Image size 2048x1536 — 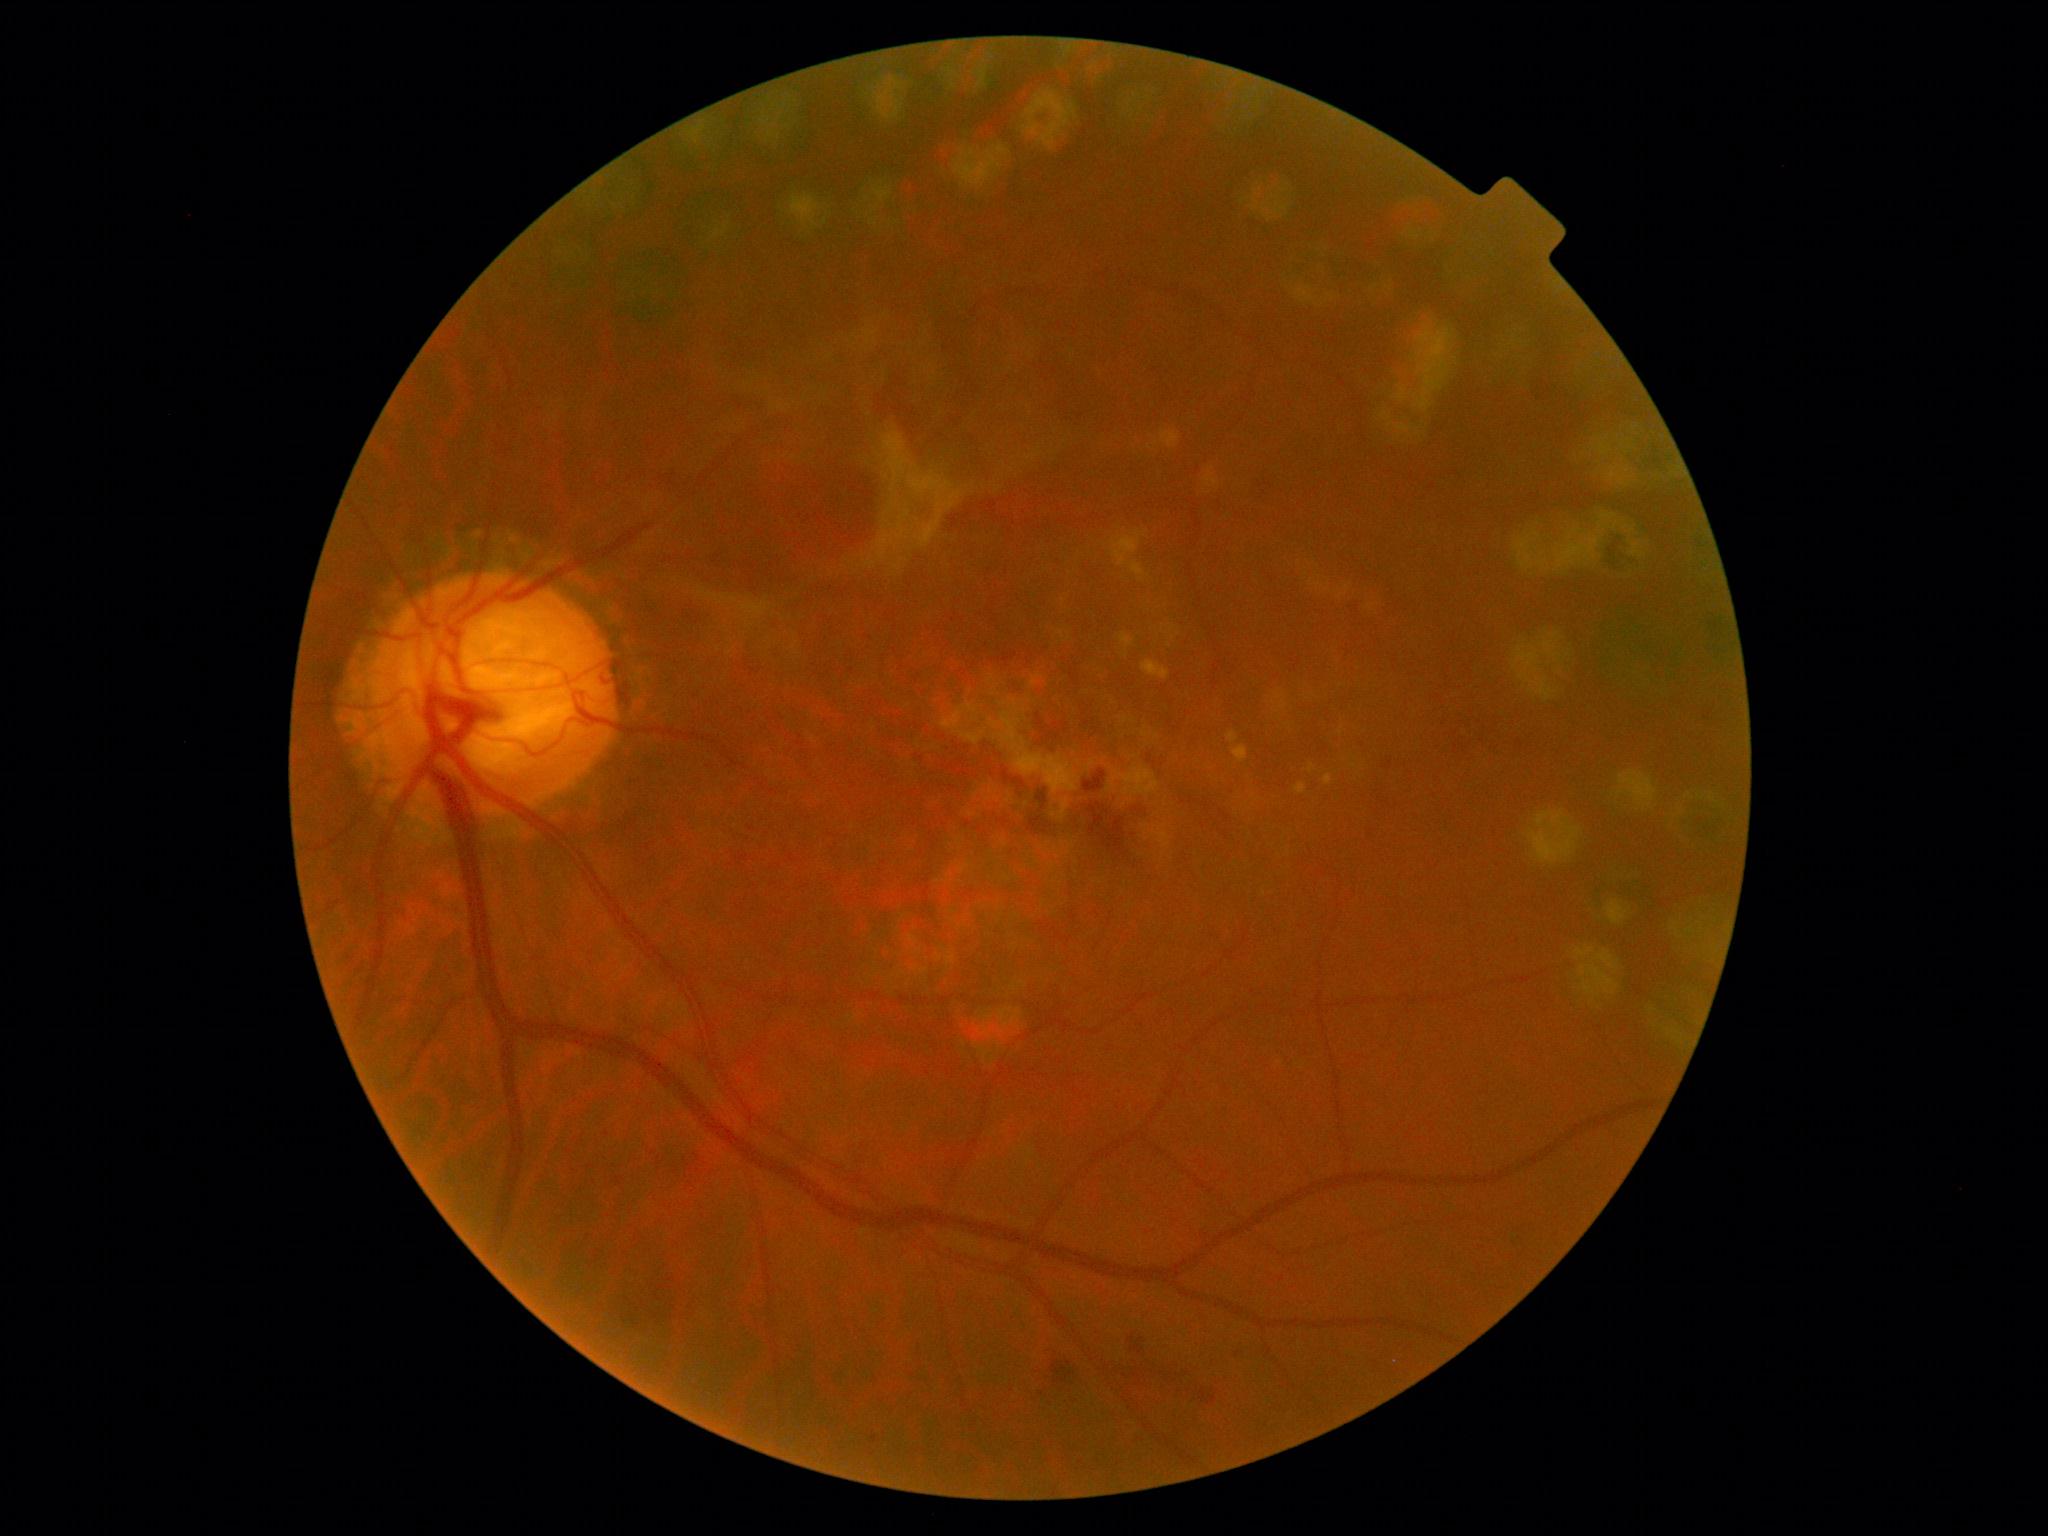
DR severity: PDR (grade 4) — neovascularization and/or vitreous/pre-retinal hemorrhage